2352x1568, 45° field of view, fundus photo
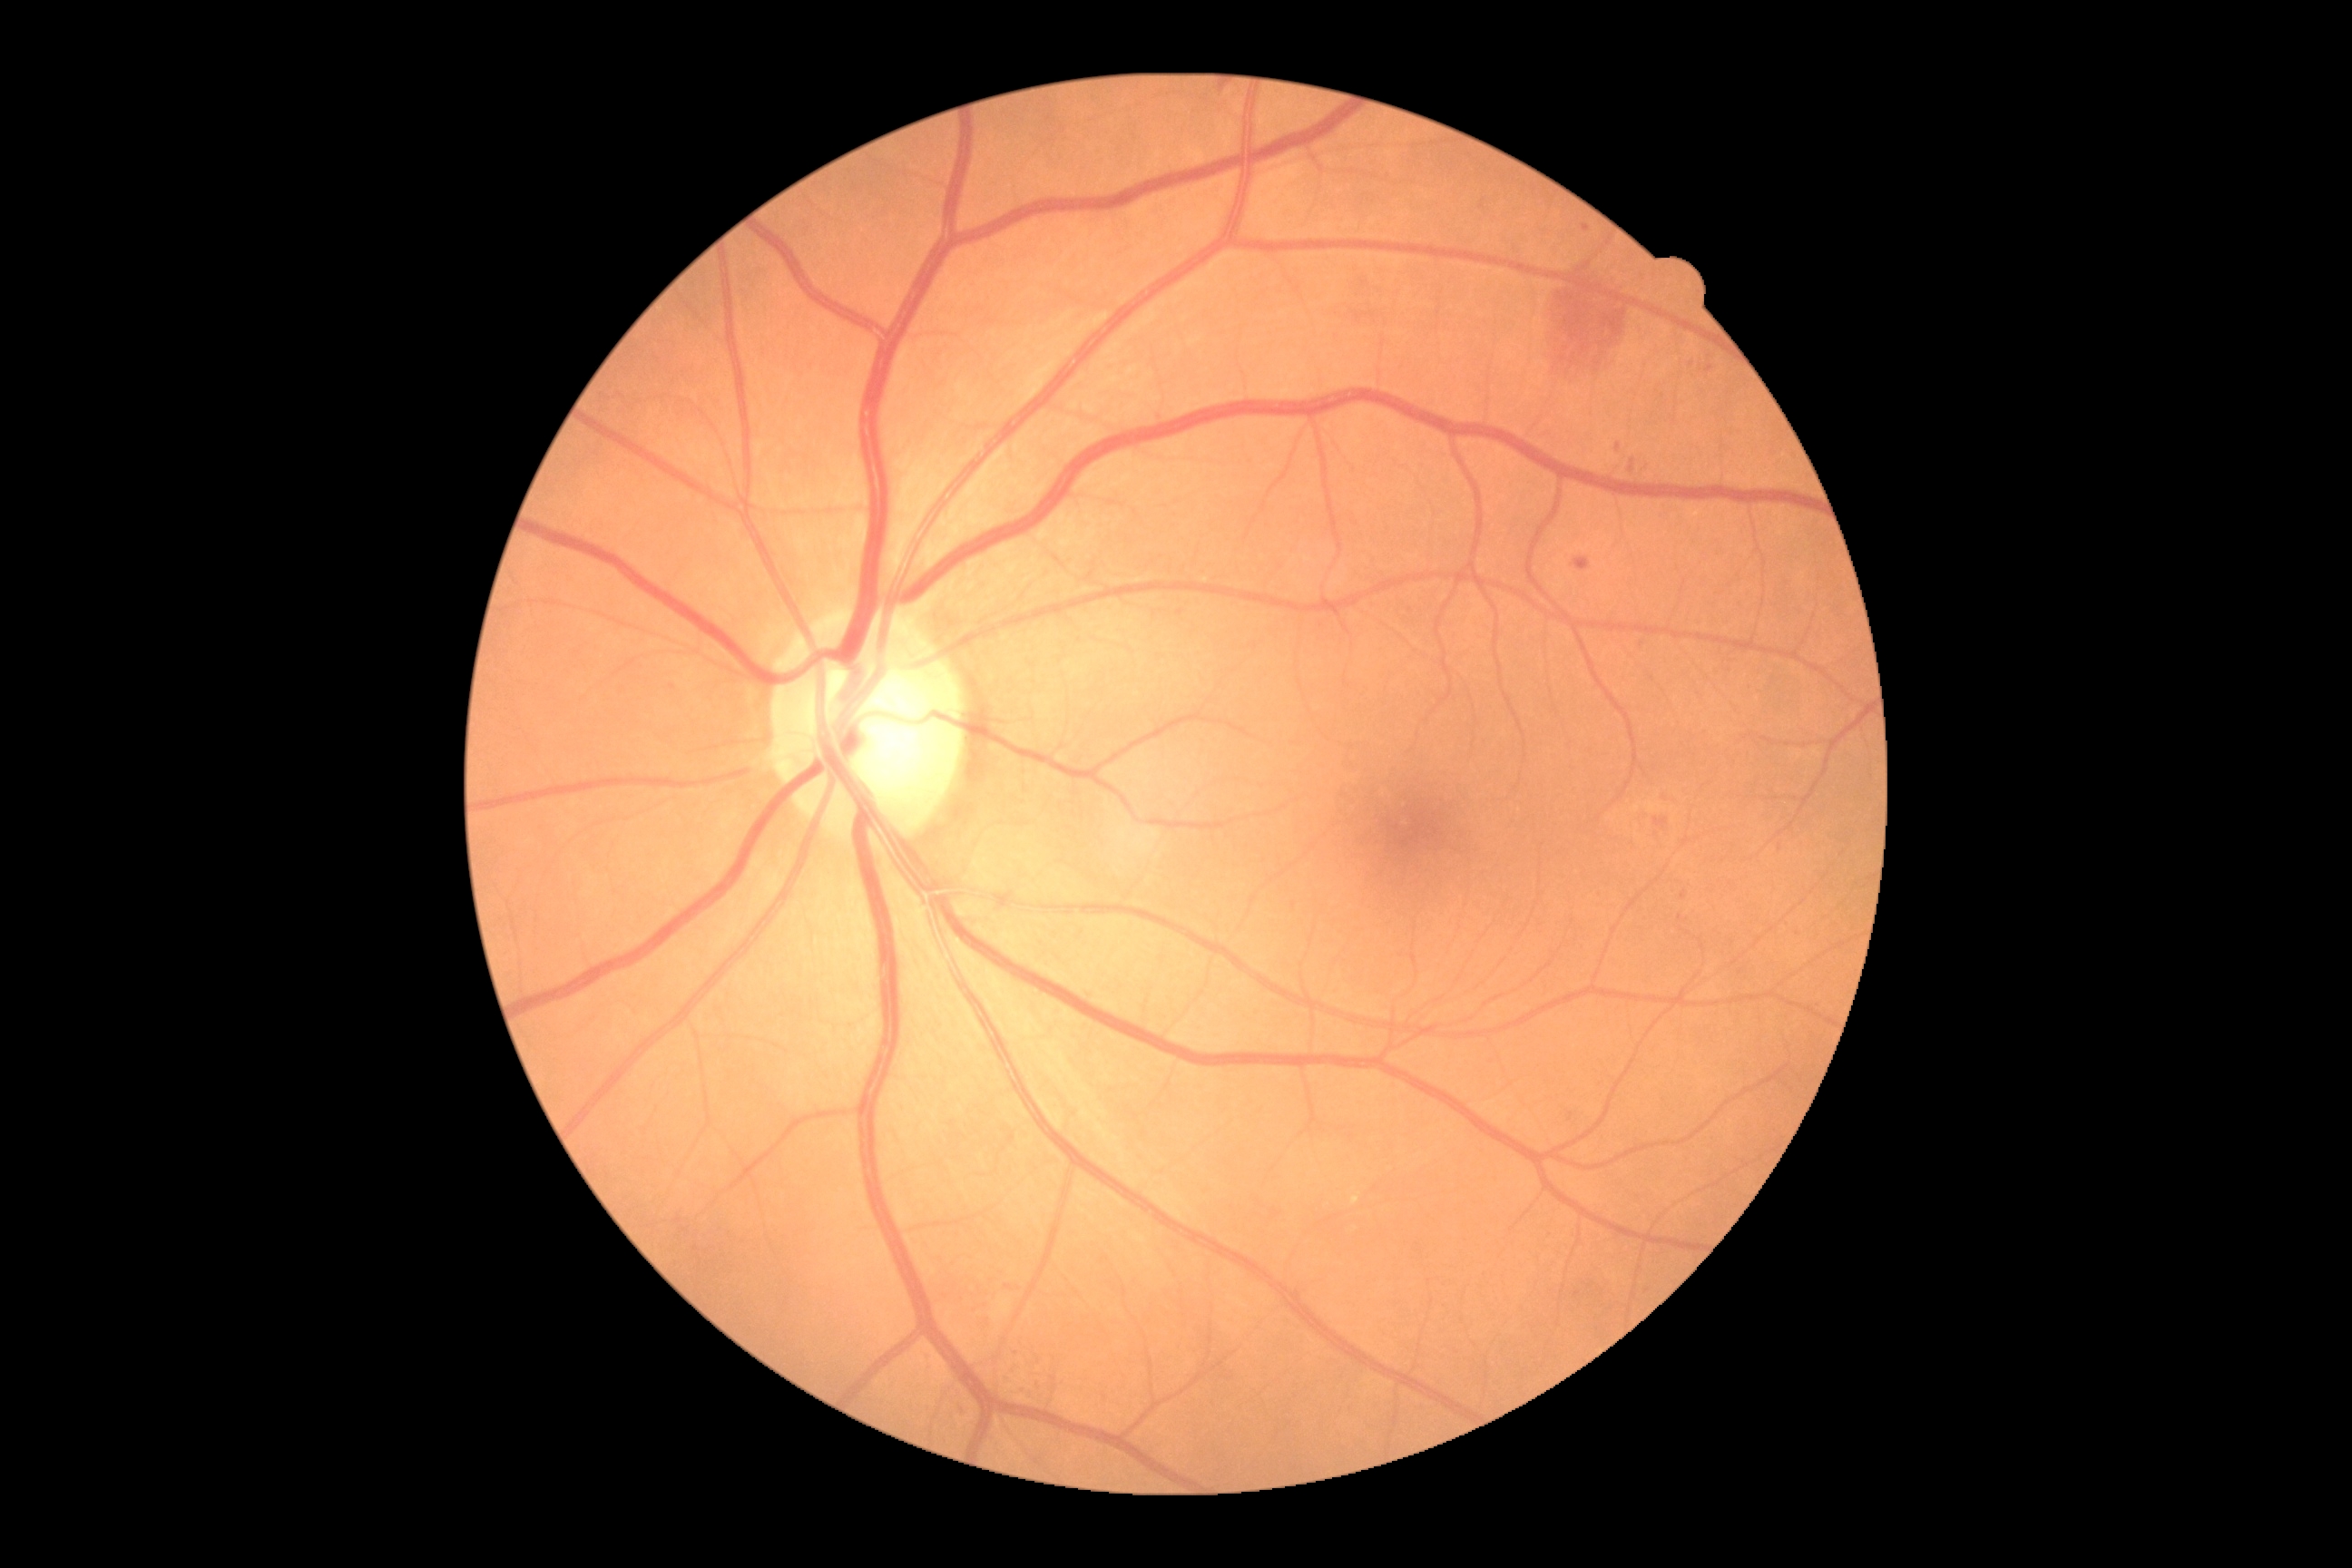   dr_grade: 2 (moderate NPDR)